Davis DR grading: 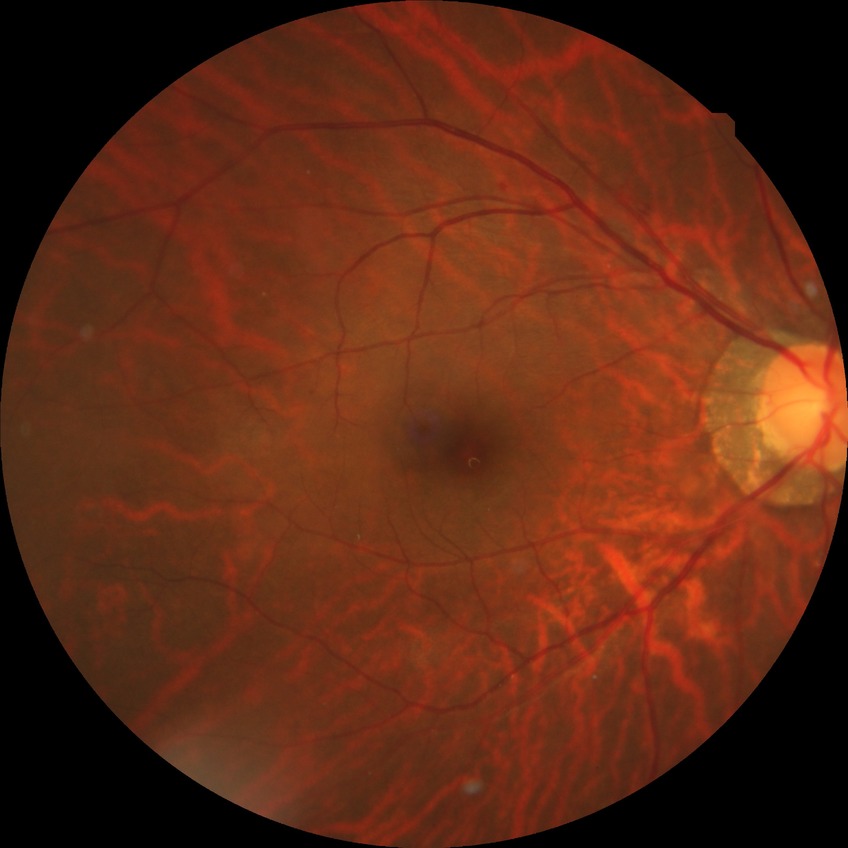 Findings:
* diabetic retinopathy (DR): NDR (no diabetic retinopathy)